Captured with the Clarity RetCam 3 (130° field of view); wide-field contact fundus photograph of an infant:
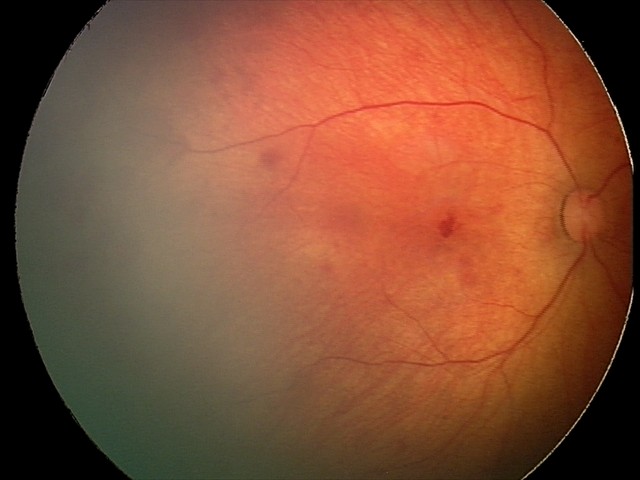
From an examination with diagnosis of retinal hemorrhages.